60° FOV; portable fundus camera image; 2212 x 1659 pixels:
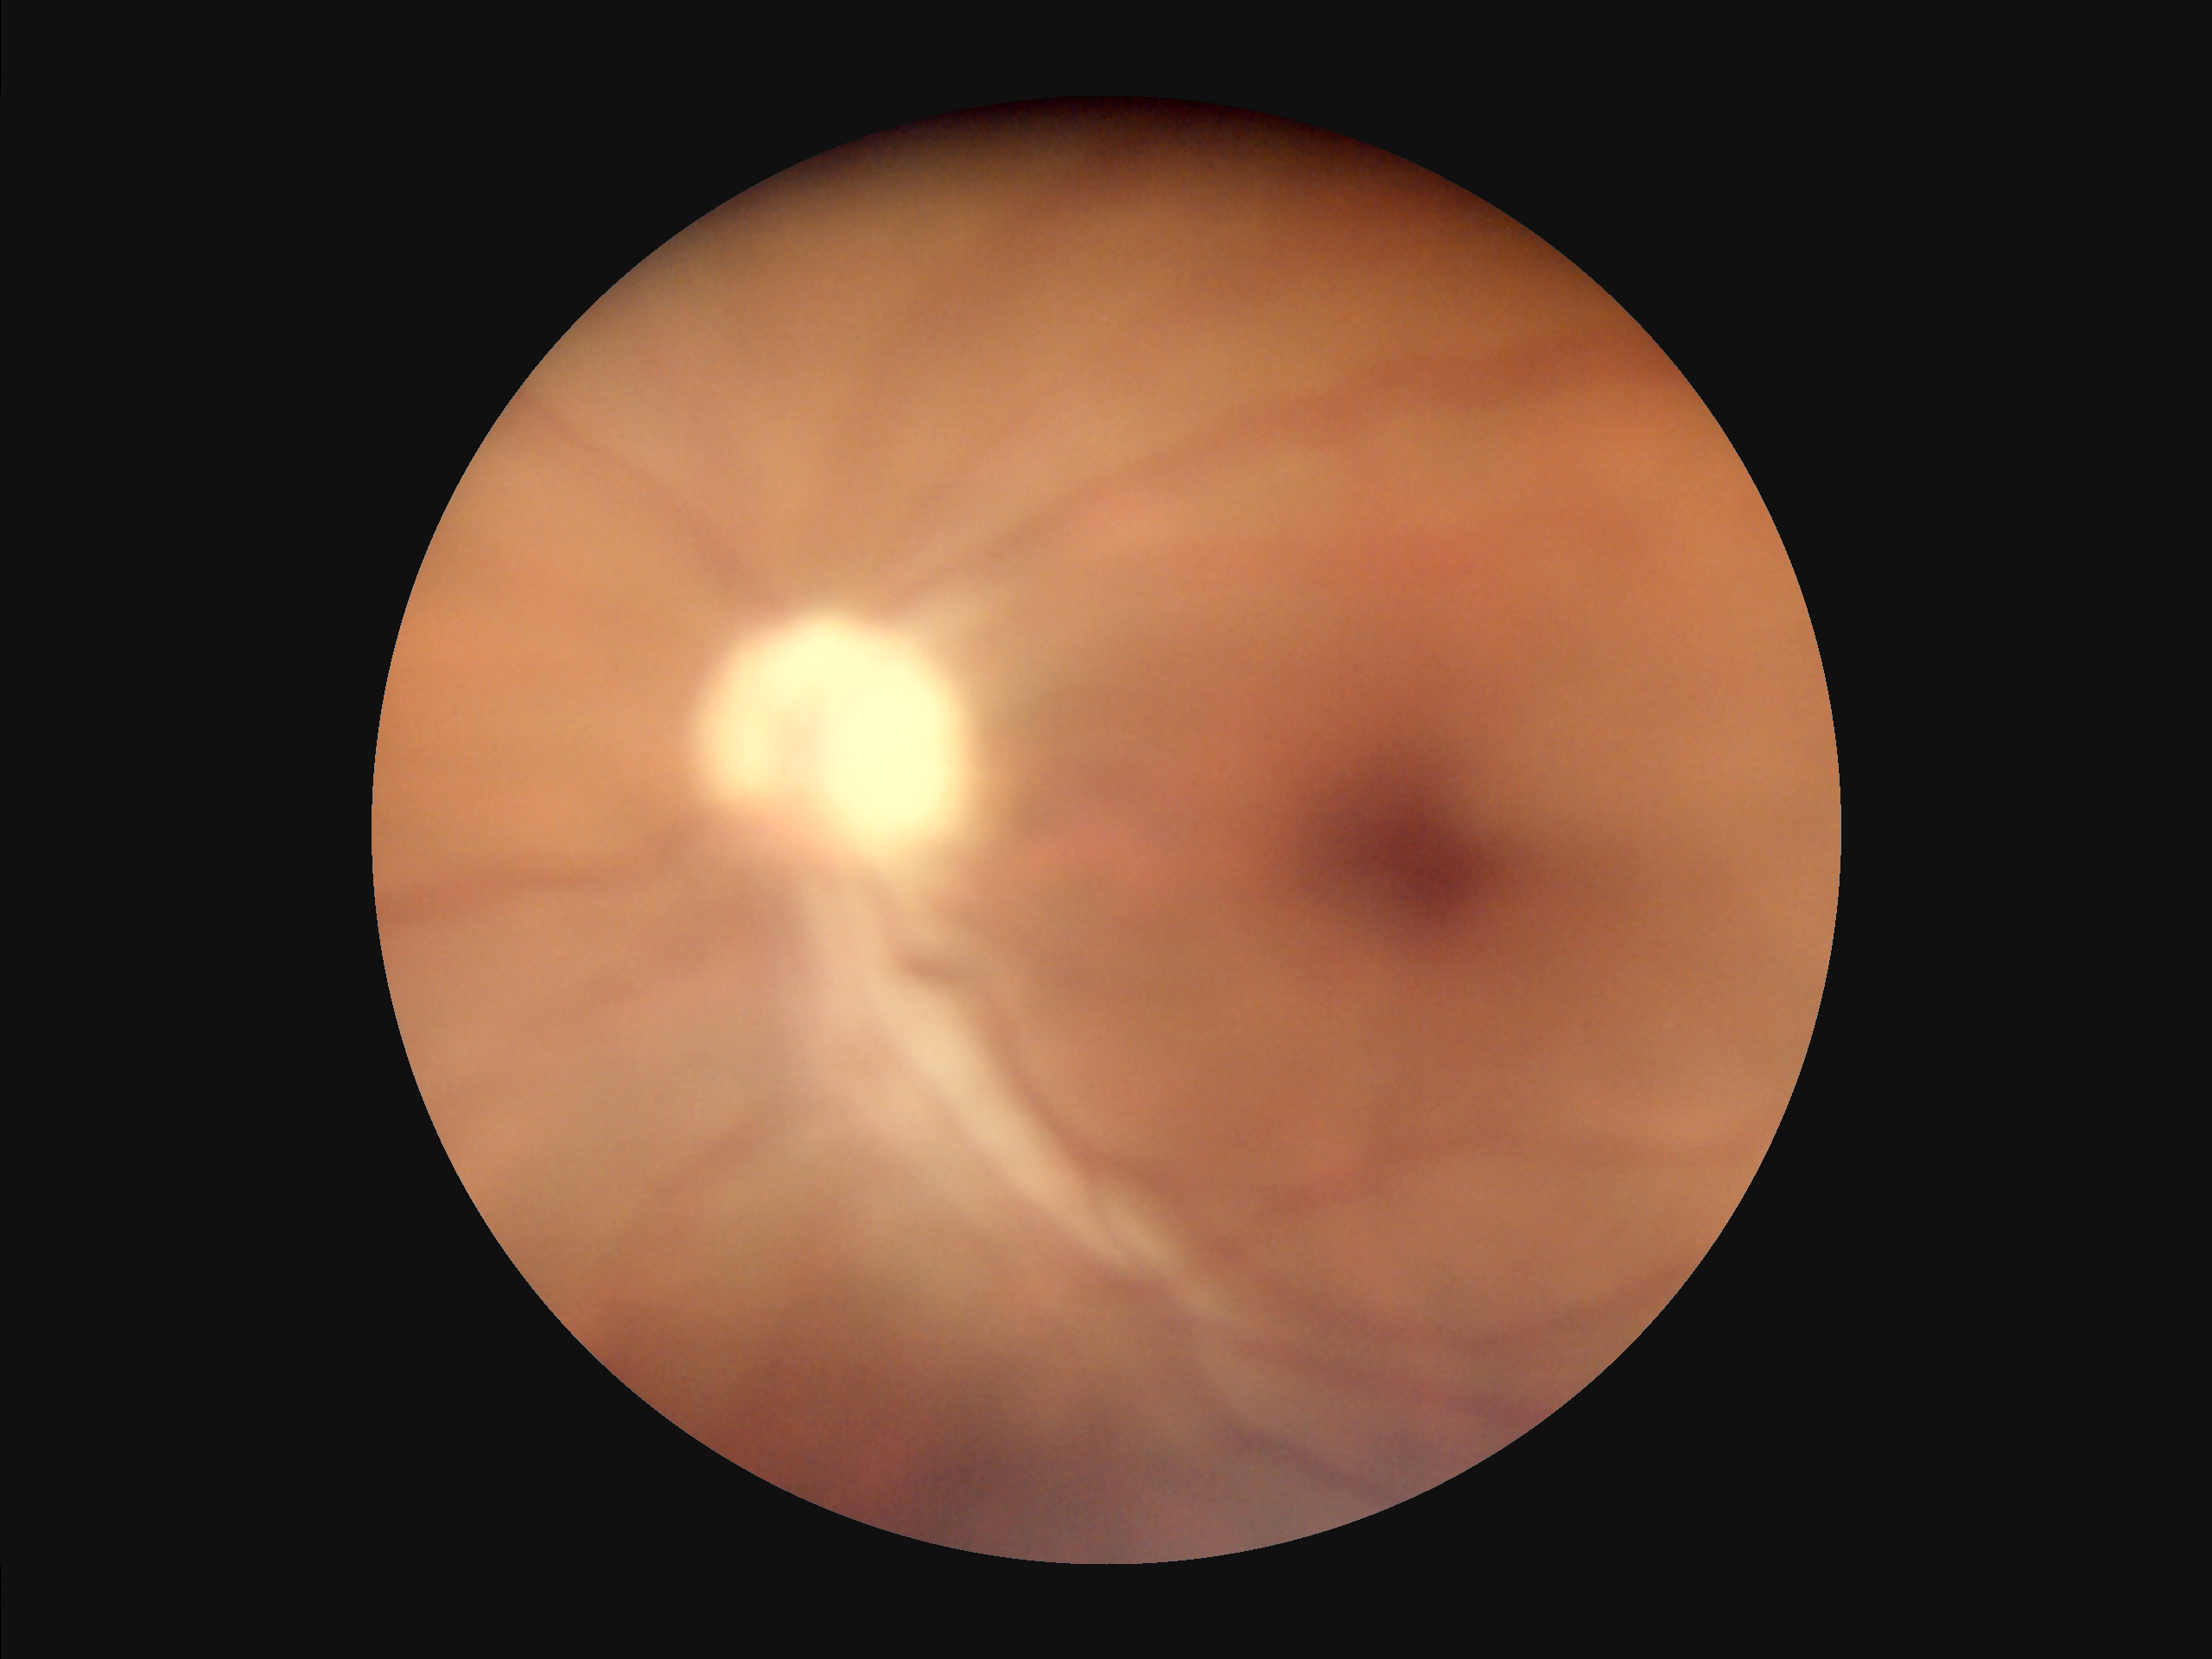
Quality grading: contrast: low | illumination/color: good | overall: suboptimal | sharpness: blurry.